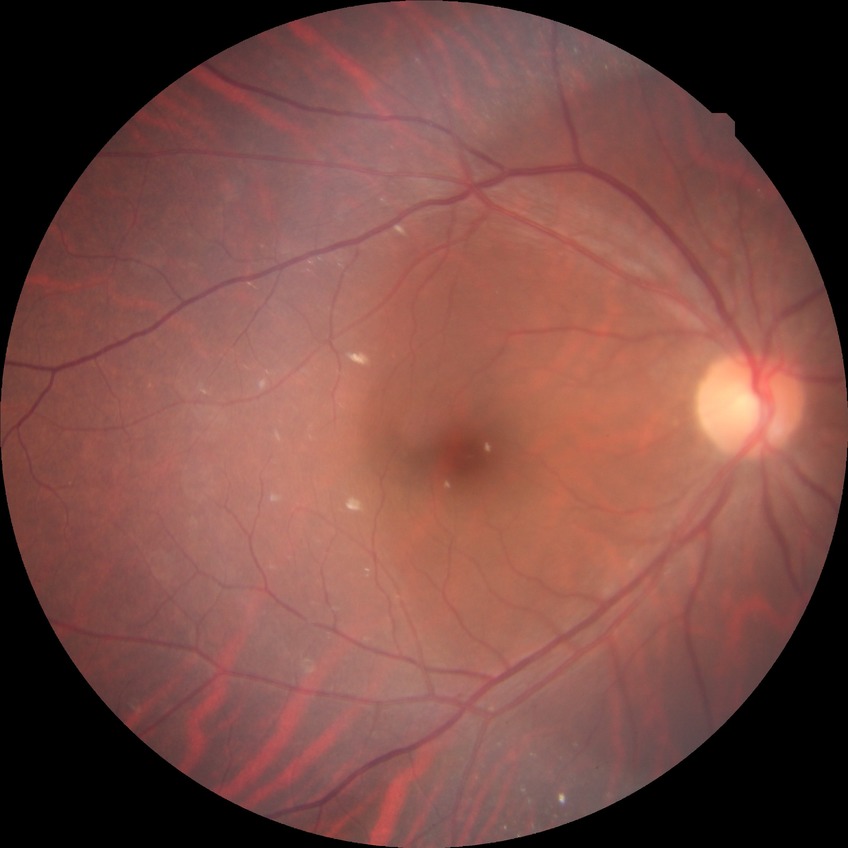
modified Davis grading: no diabetic retinopathy.